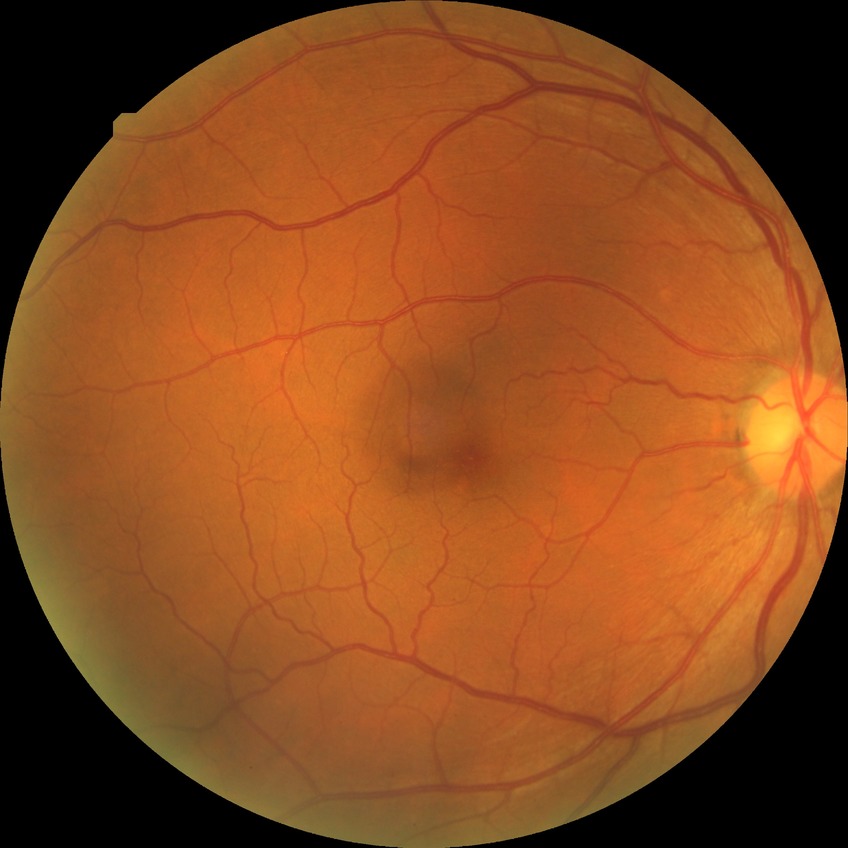 No DR findings.
Modified Davis grade: NDR.